1659x2212px: 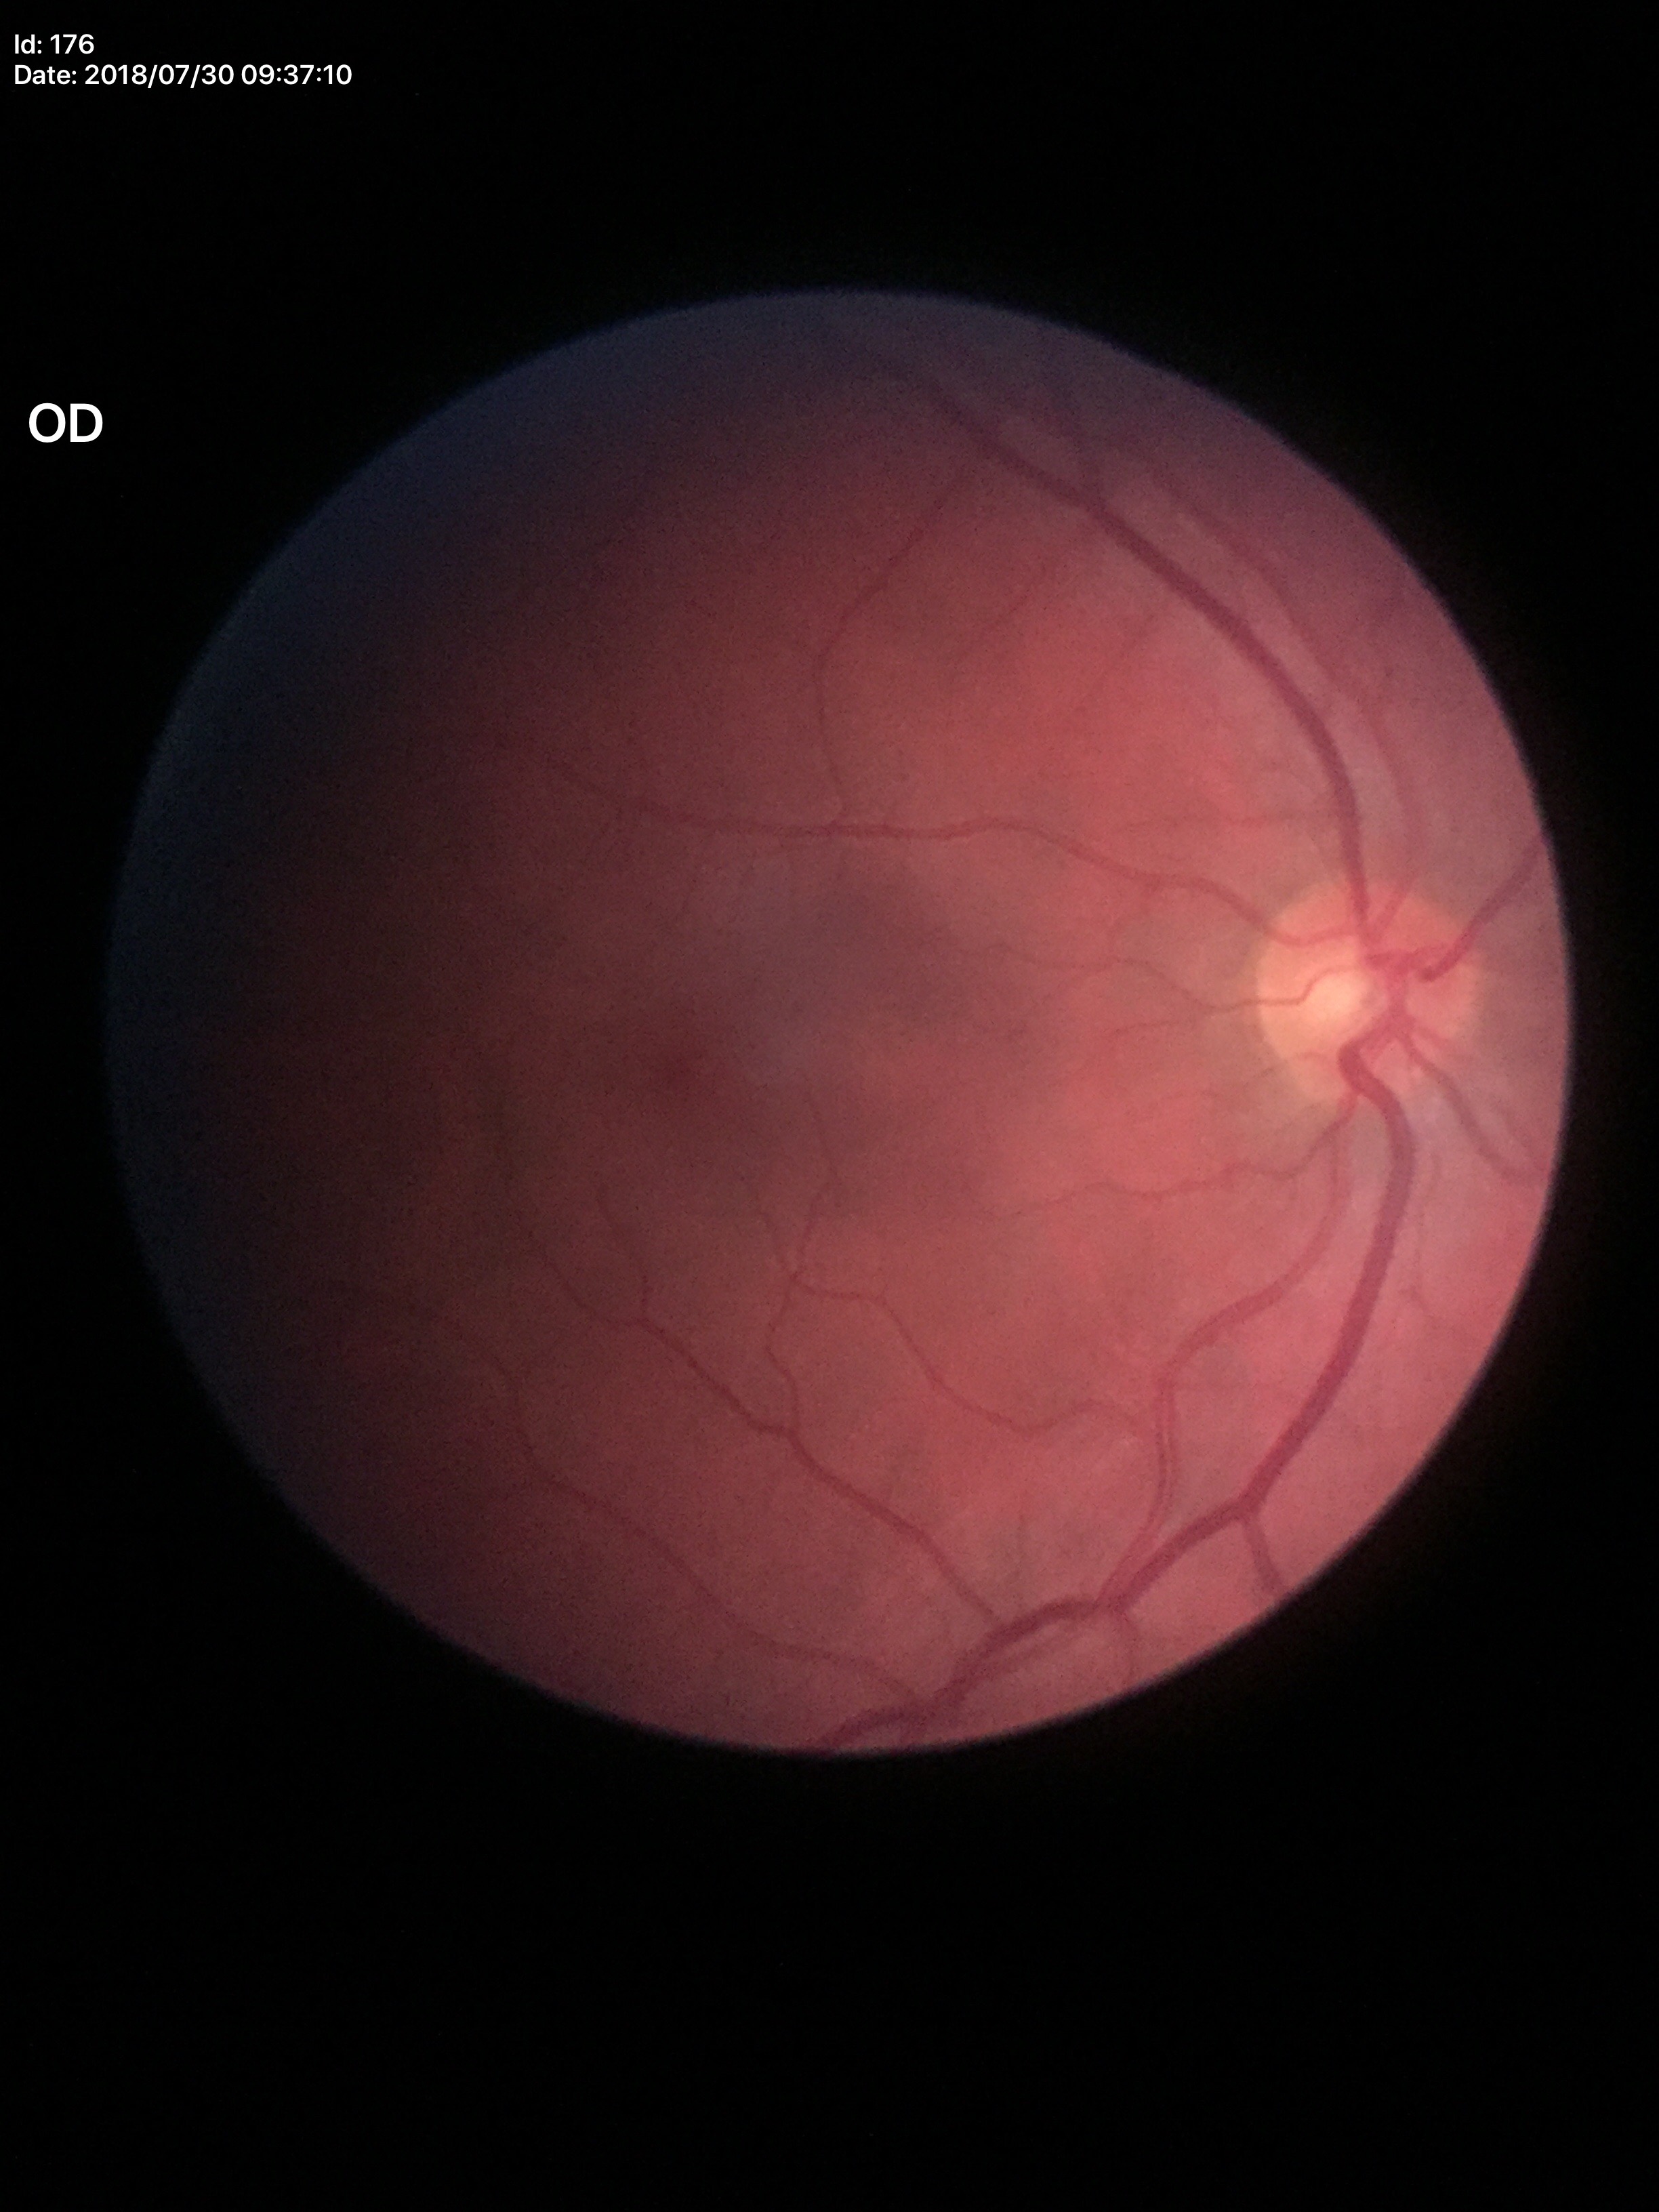
Glaucoma screening = no suspicious findings | vertical cup-to-disc ratio = 0.57.